1659x2212 · acquired with a Remidio smartphone fundus camera.
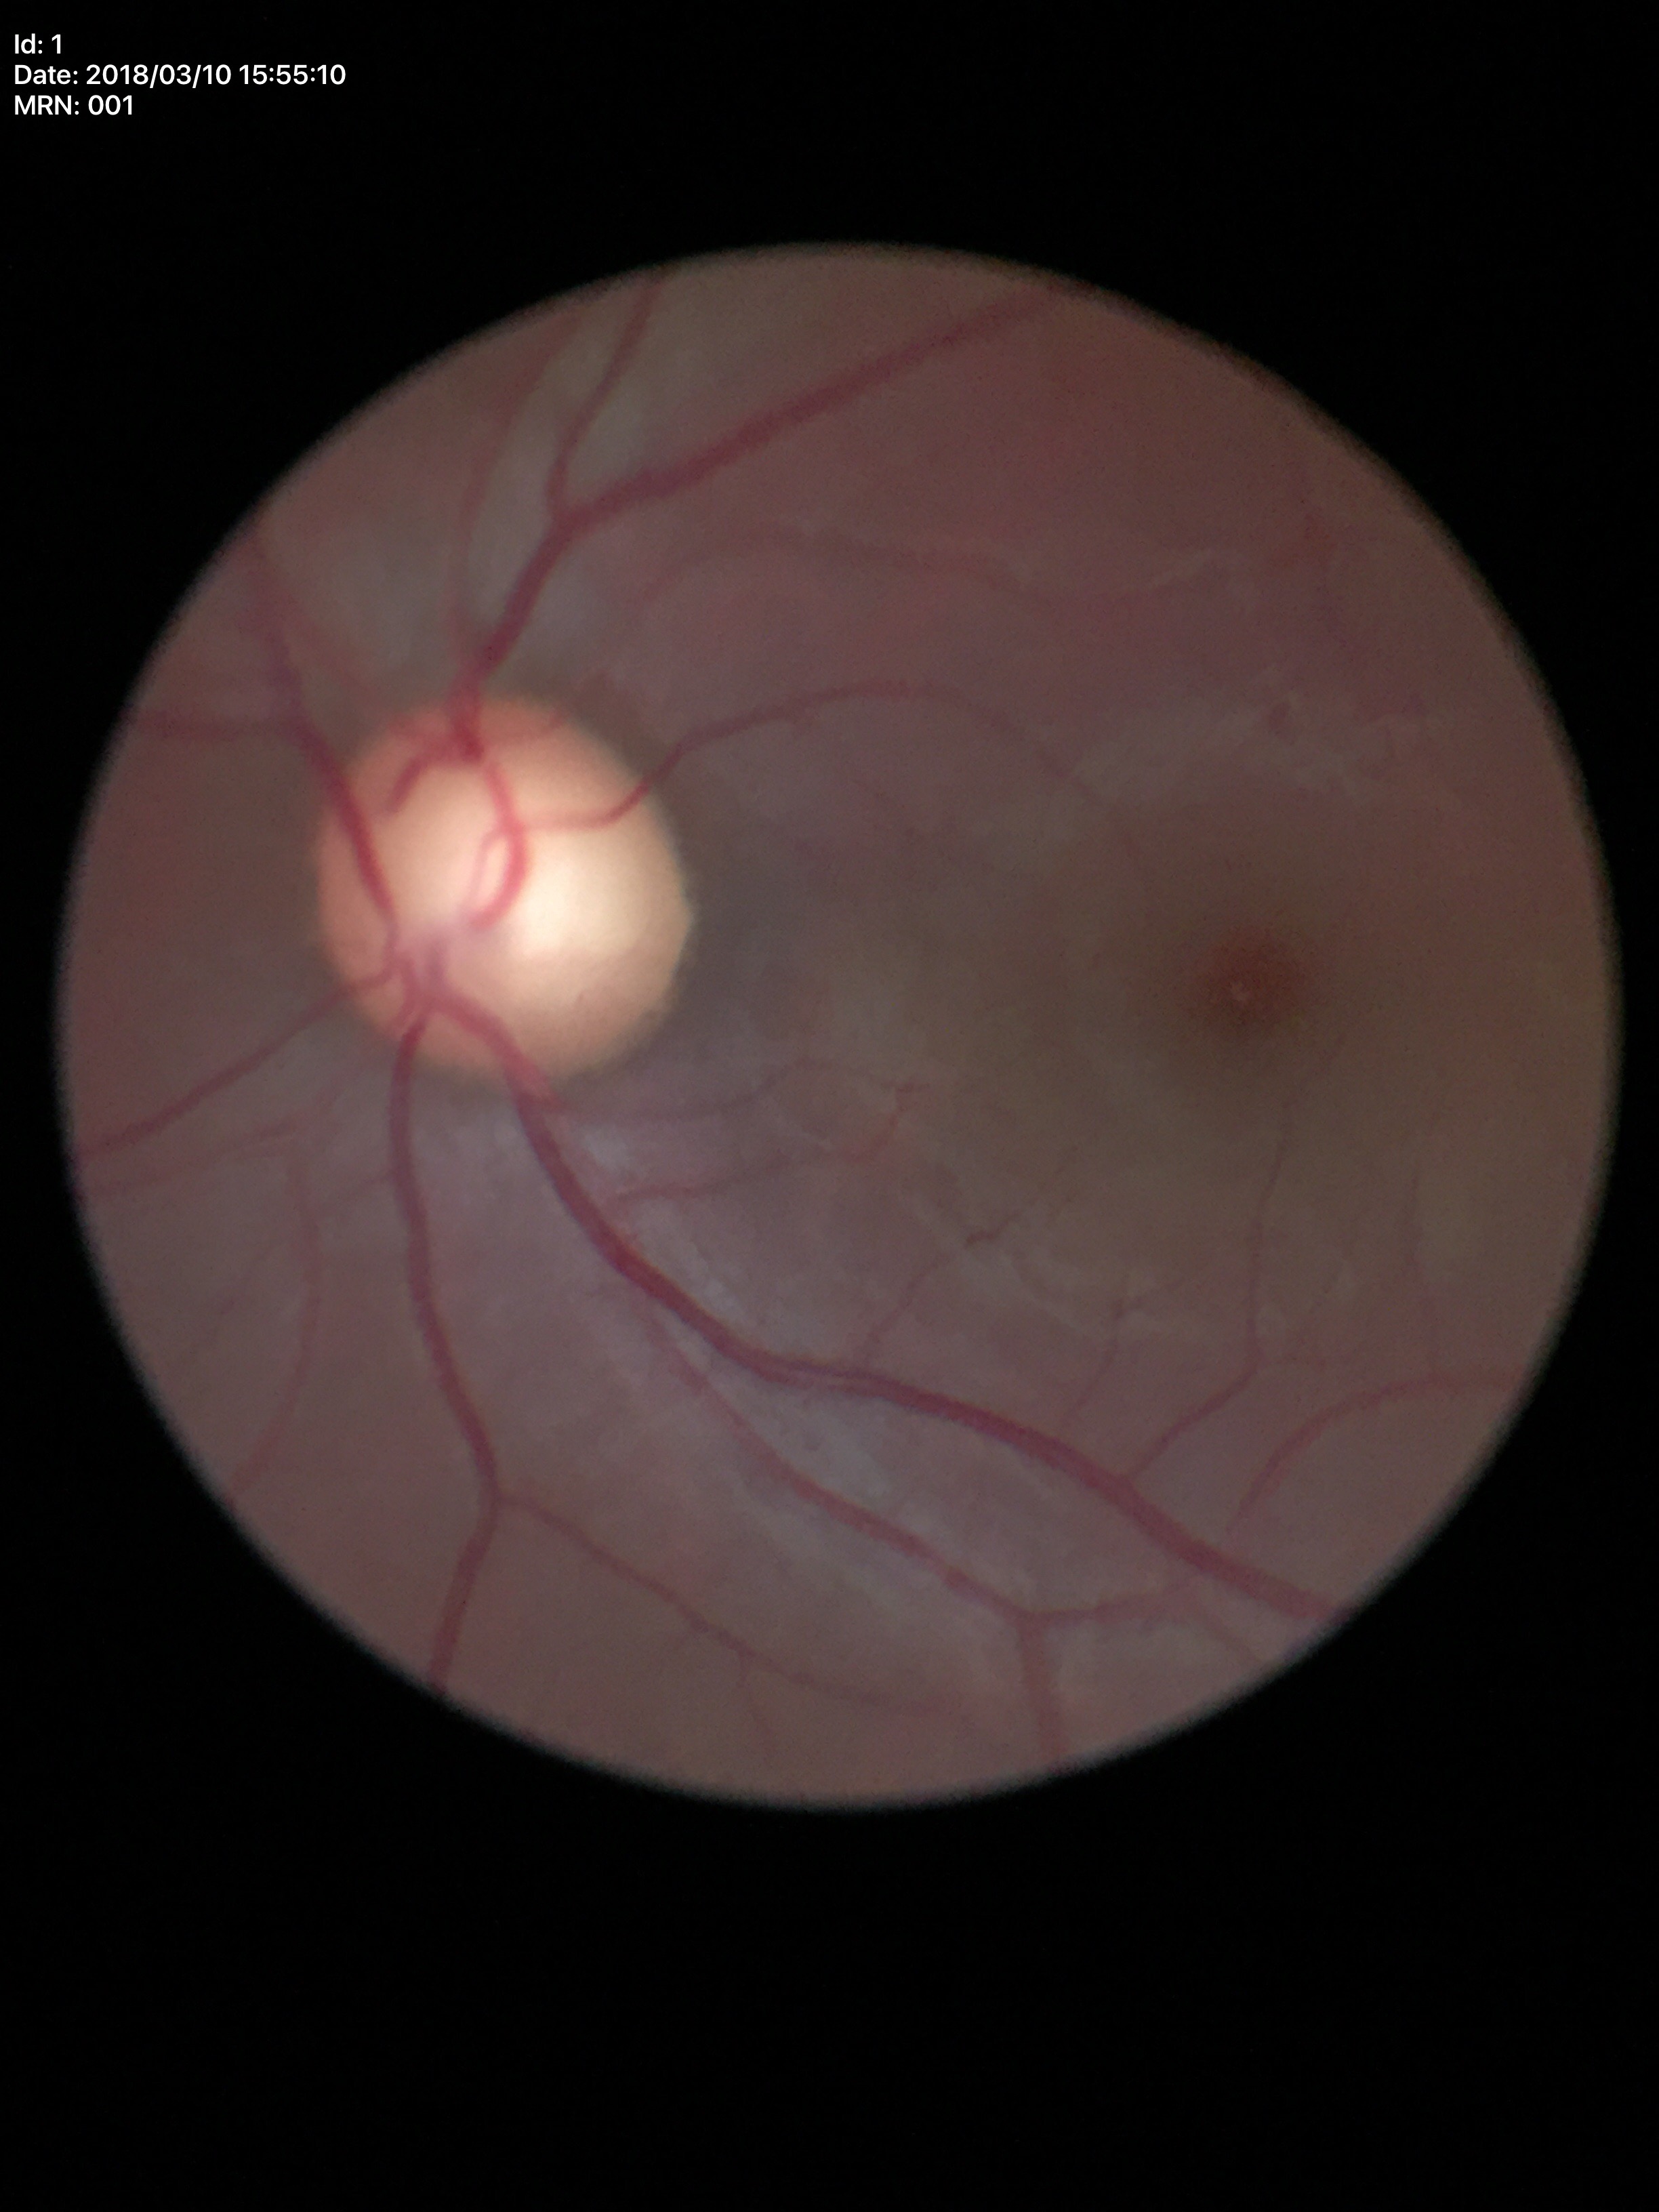 {
  "glaucoma_decision": "suspect",
  "vcdr": "0.70"
}